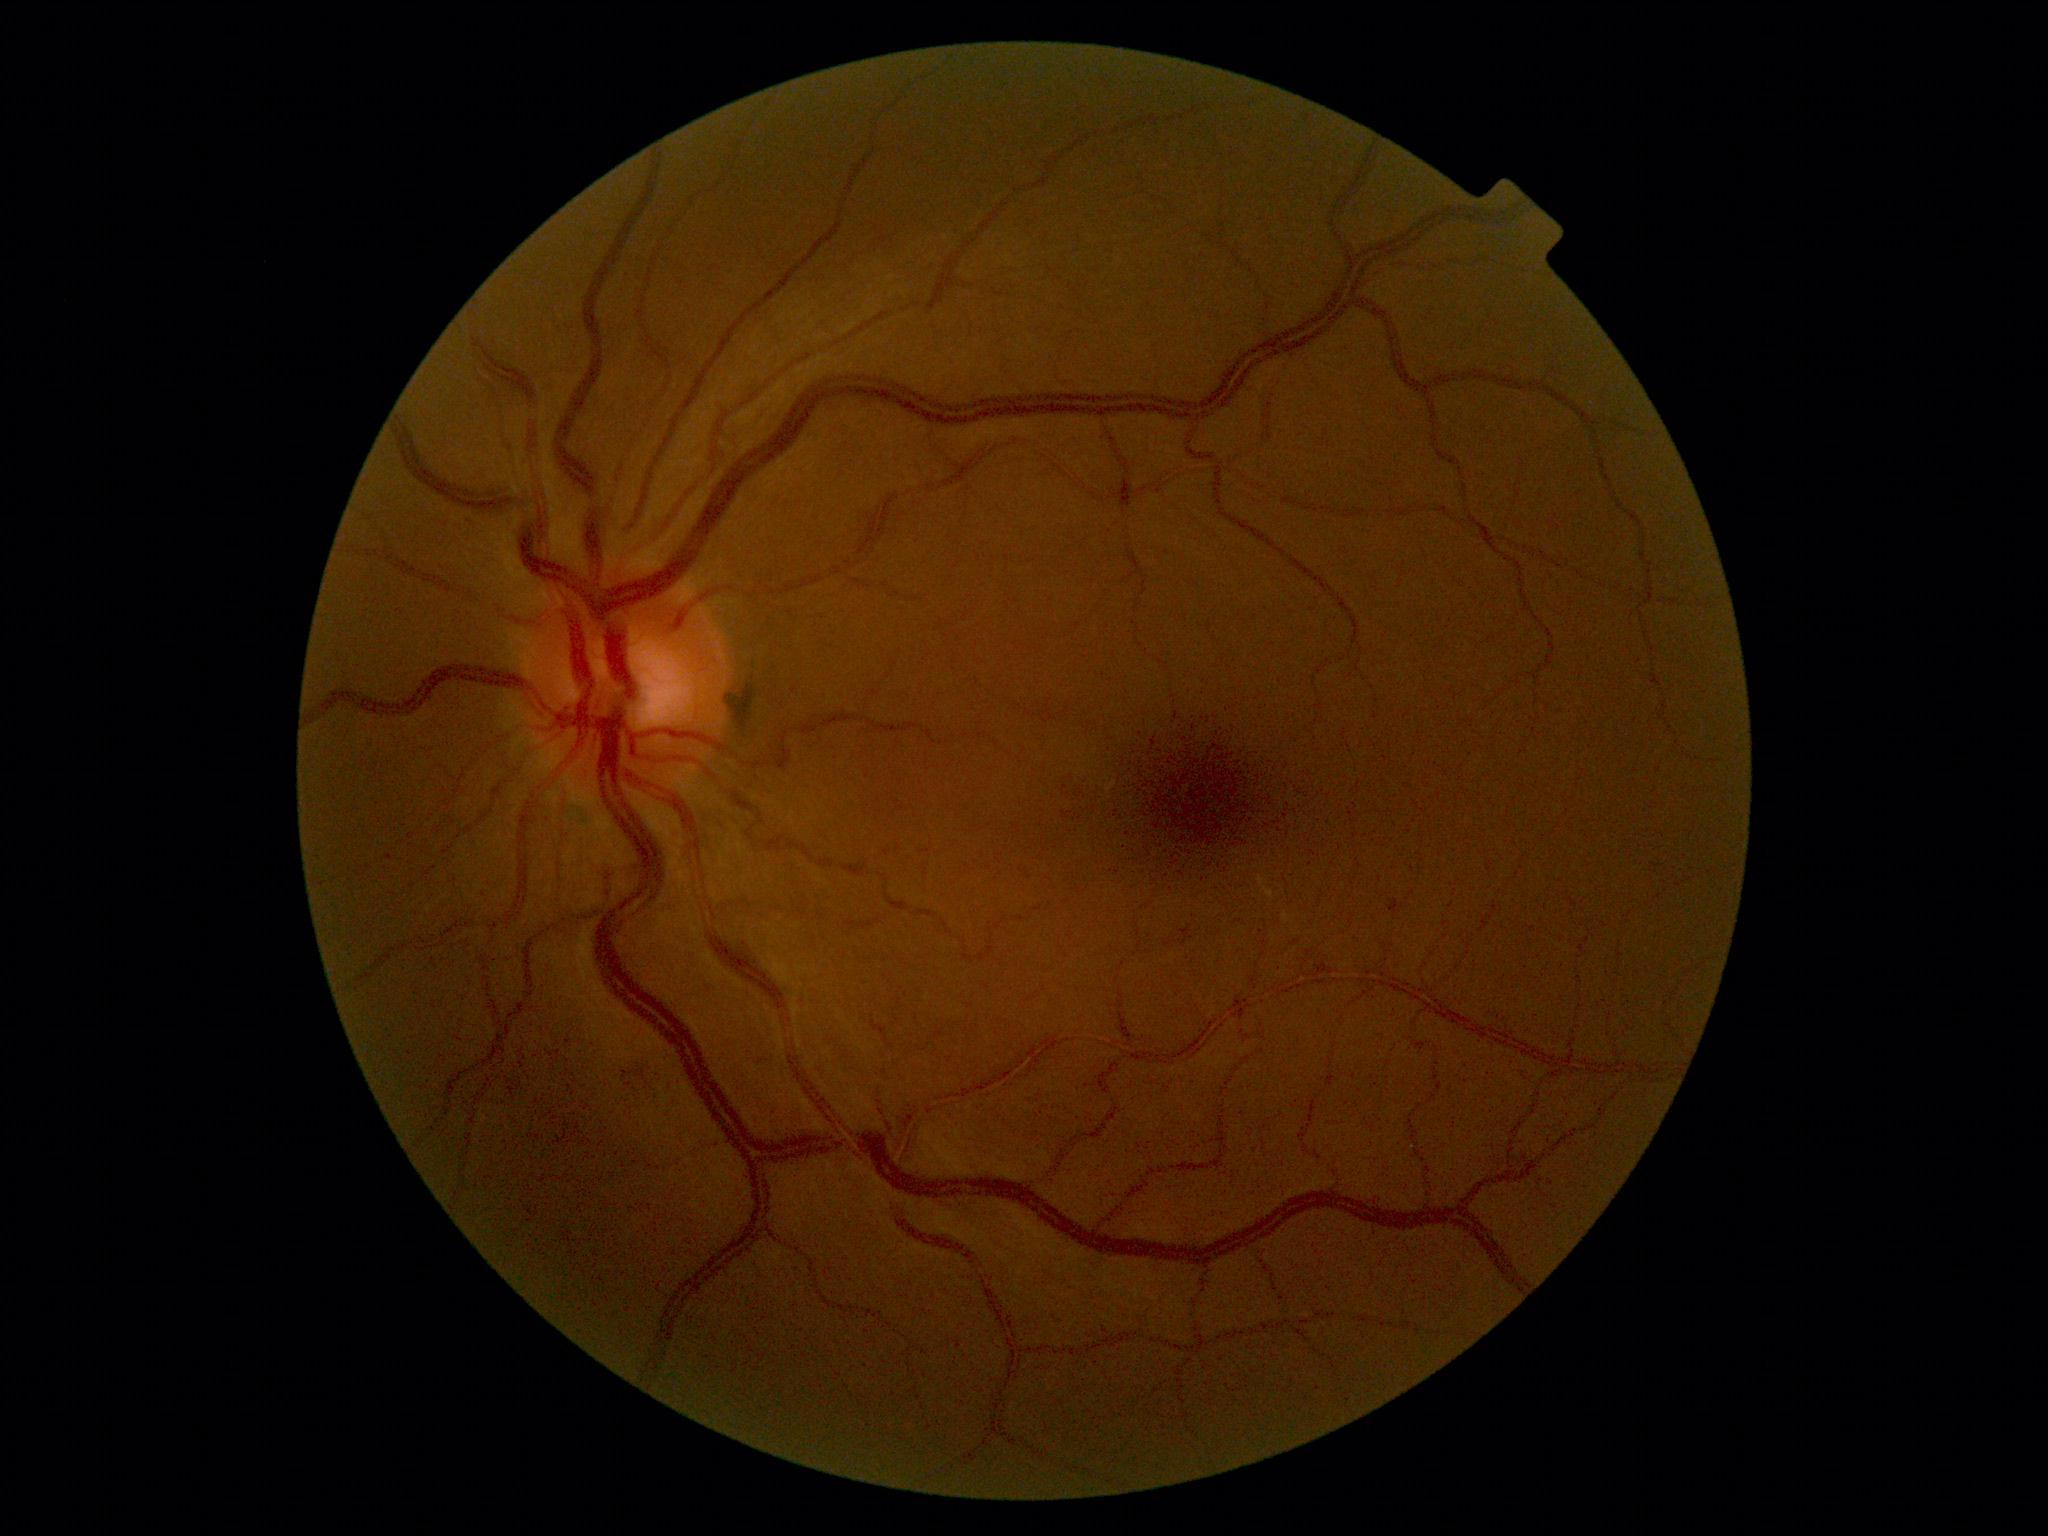

The retinopathy is classified as non-proliferative diabetic retinopathy. Diabetic retinopathy (DR) is grade 2.